RetCam wide-field infant fundus image. 1440x1080.
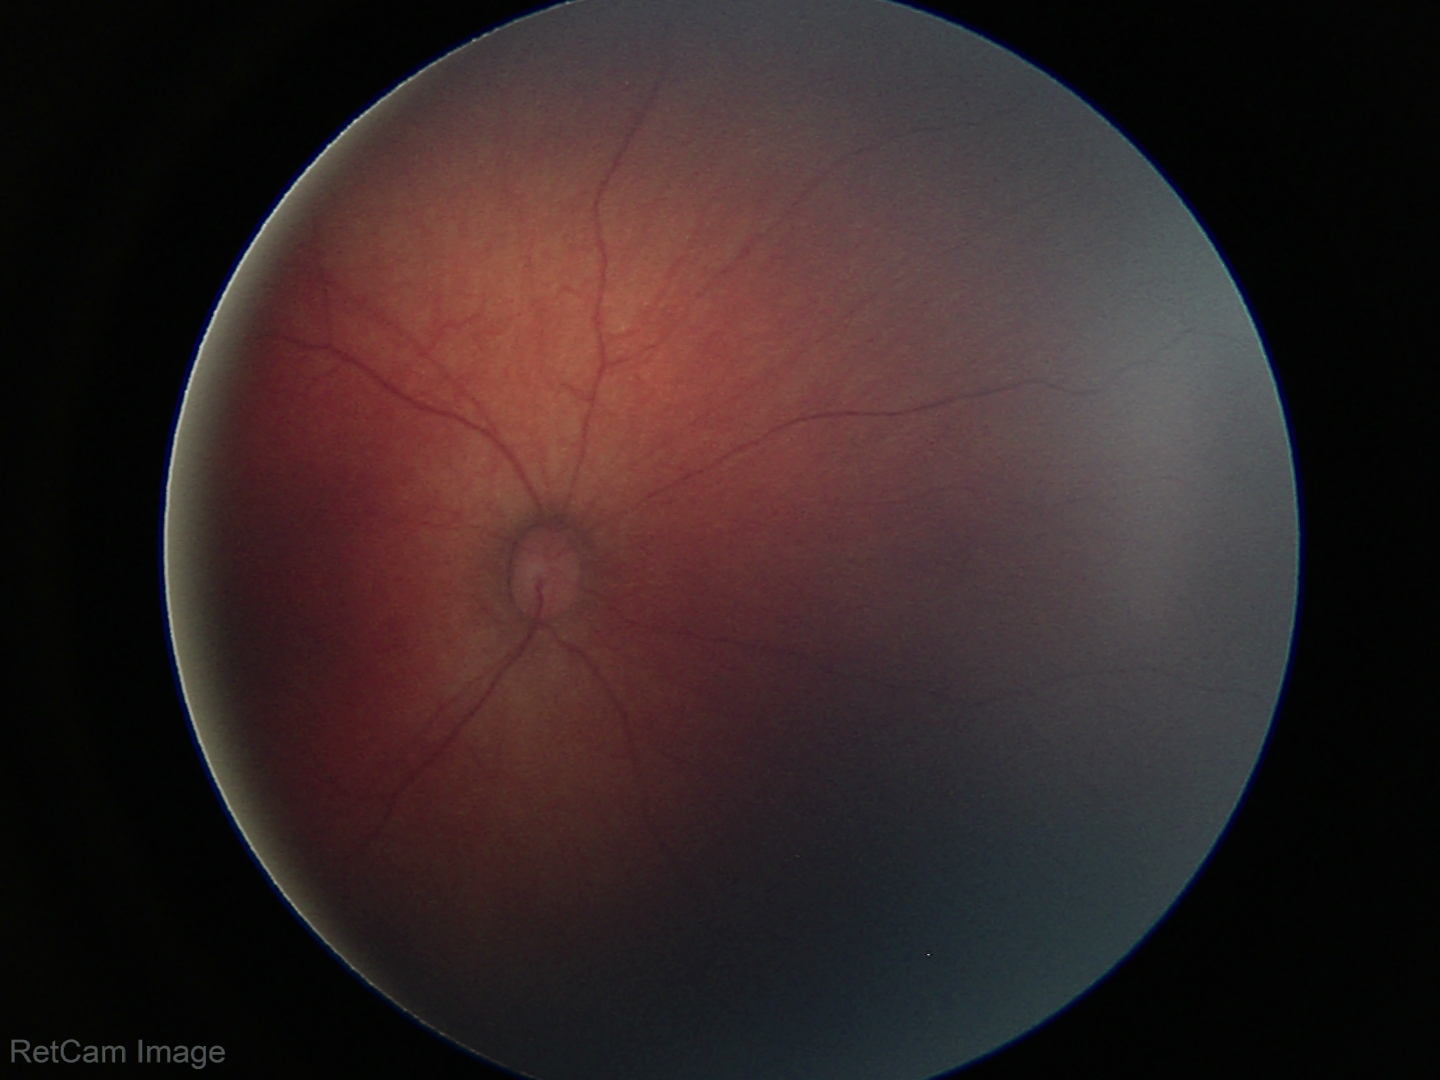 Diagnosis = physiological appearance.